640 by 480 pixels; wide-field fundus photograph from neonatal ROP screening; captured with the Clarity RetCam 3 (130° field of view)
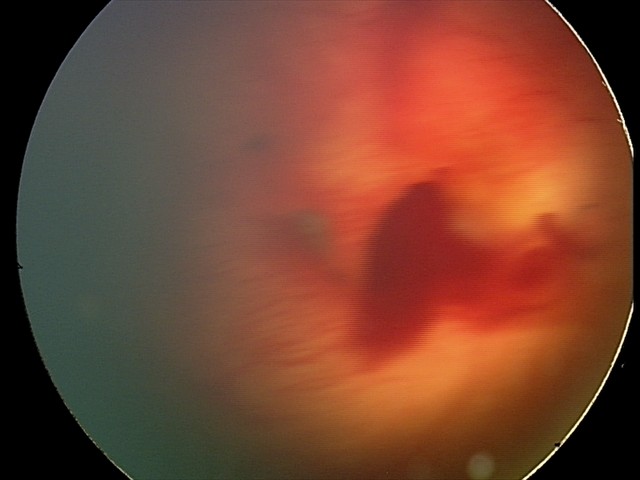

Diagnosis: retinal hemorrhages